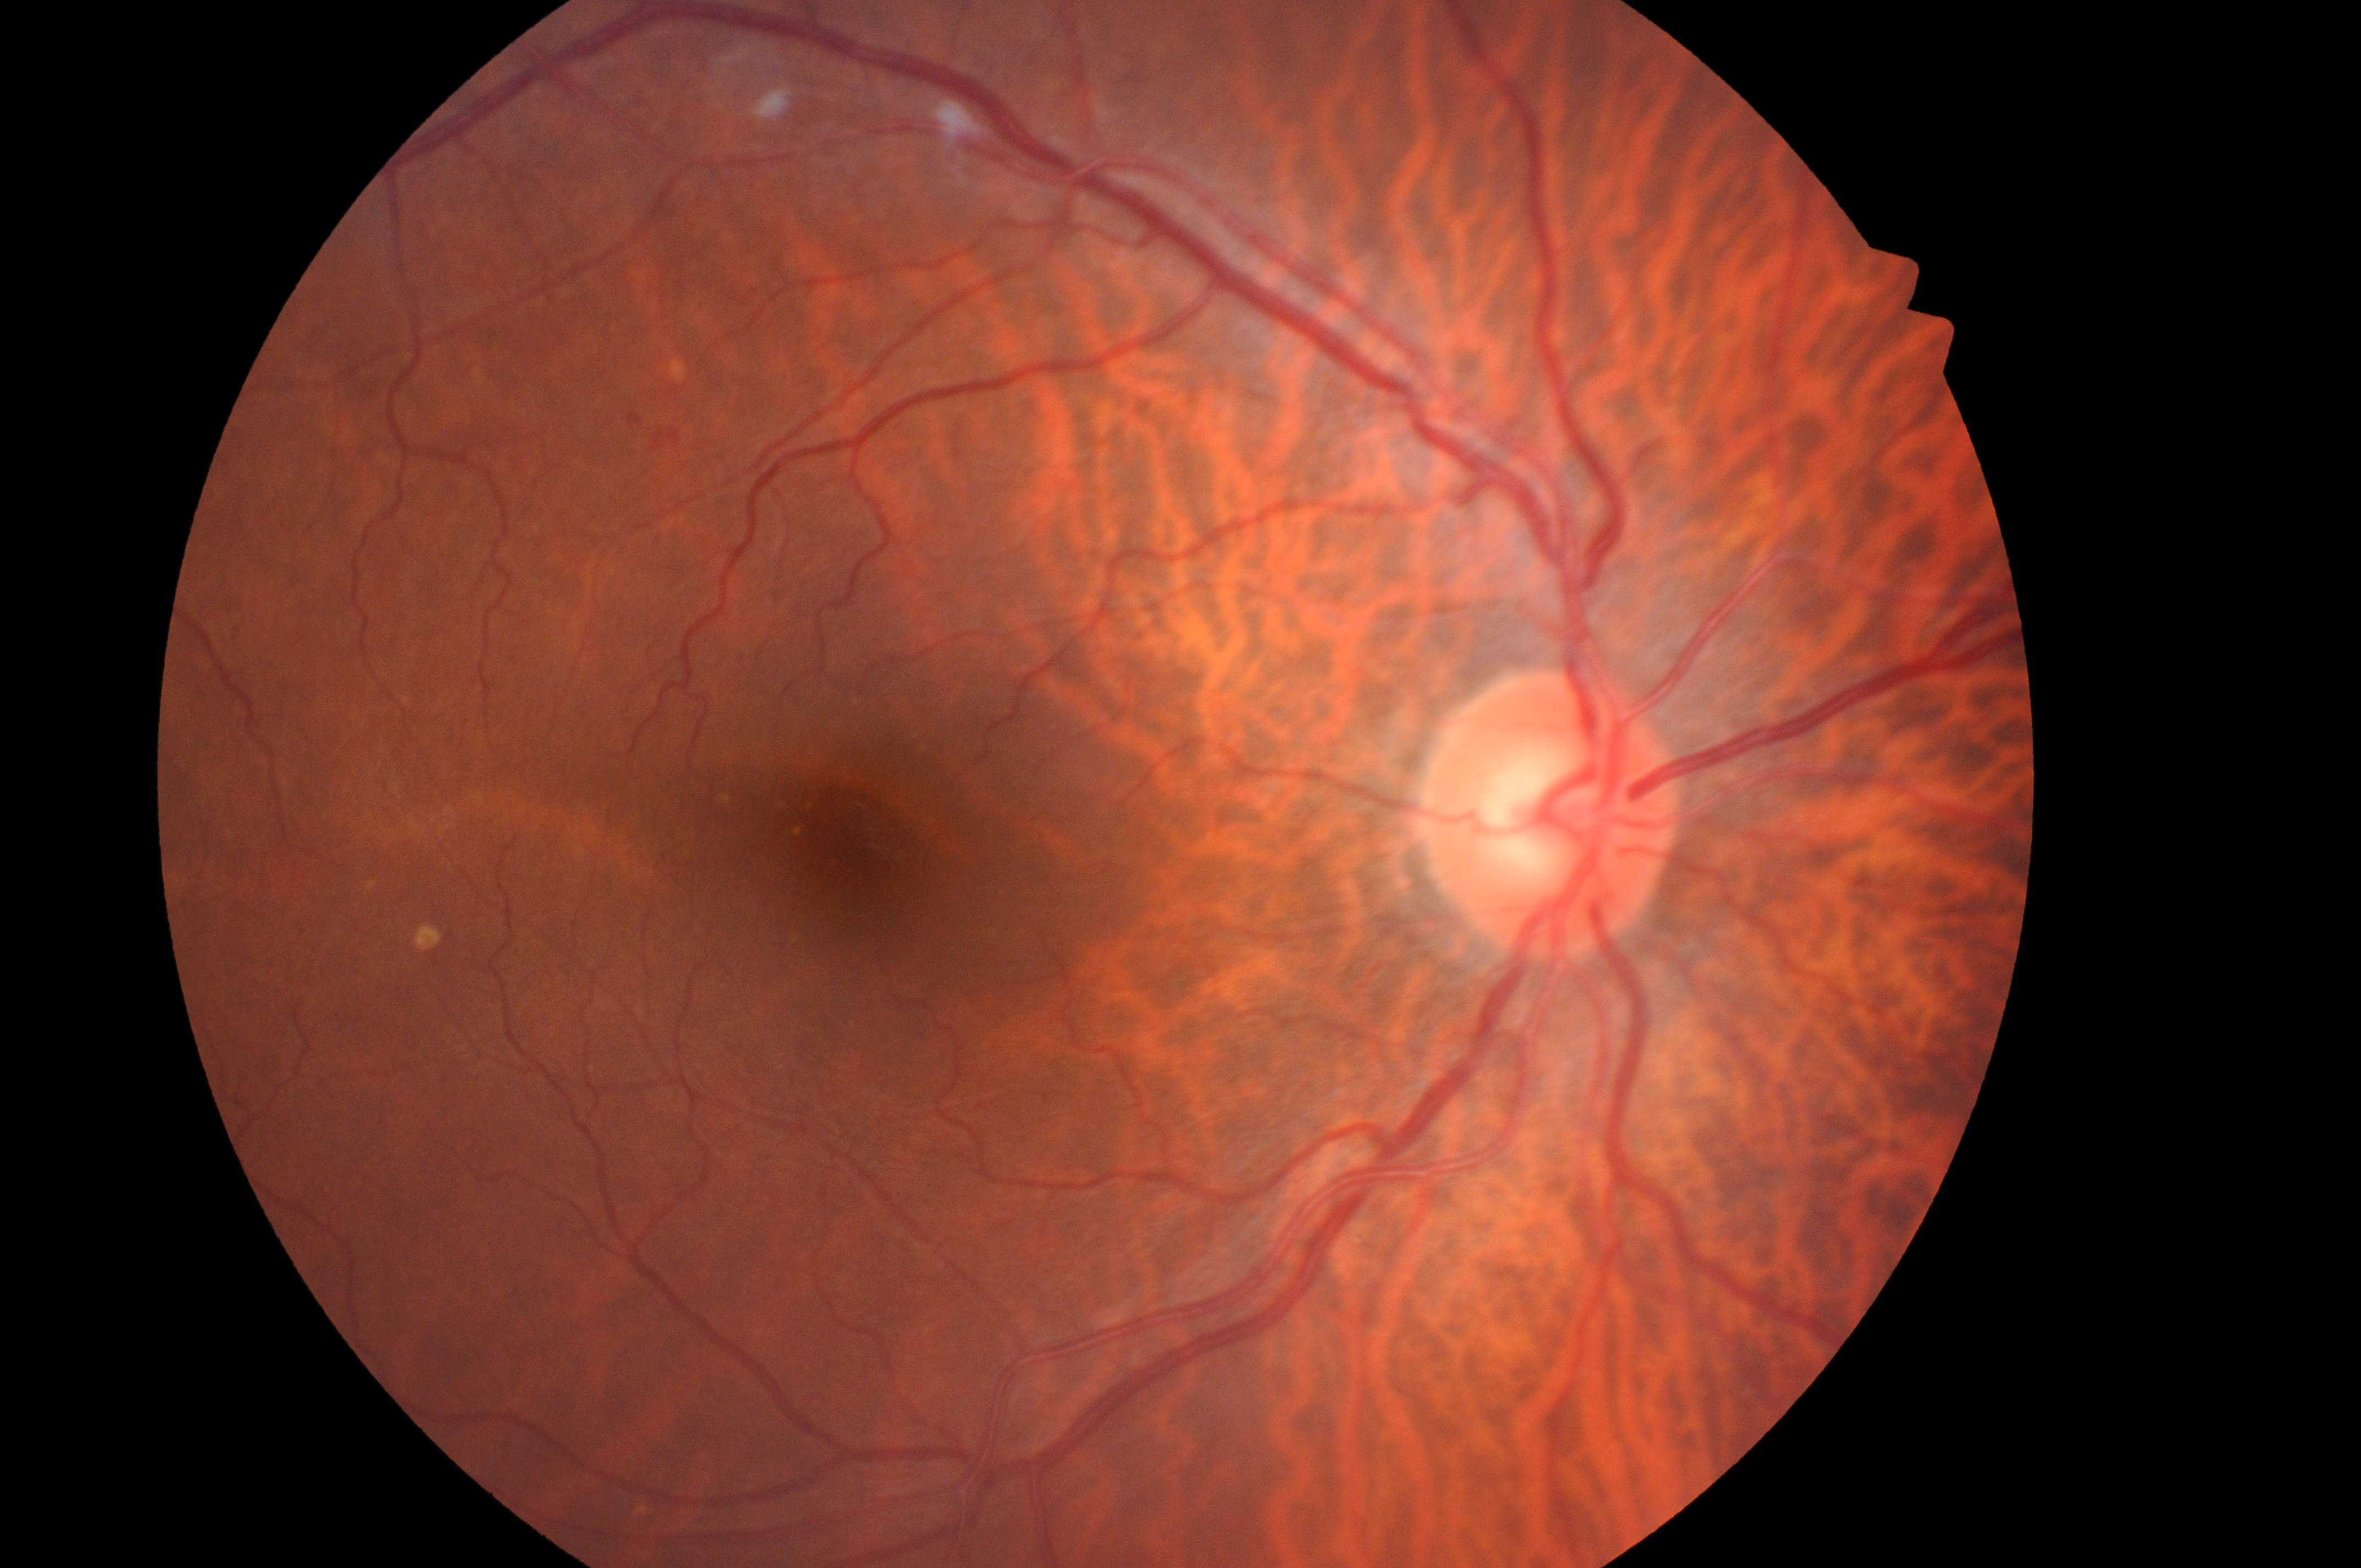
Risk of macular edema is low risk (grade 1) — hard exudates present, but outside one disc diameter of the macula center. Eye: the right eye. Diabetic retinopathy grade: 2 (moderate NPDR) — more than just microaneurysms but less than severe NPDR. ONH: (x=1549, y=823). Fovea: (x=868, y=850).